Color fundus image · non-mydriatic fundus camera: 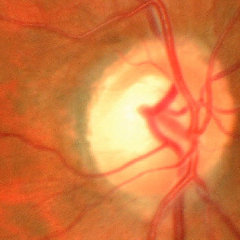
Assessment = advanced glaucoma.